848 x 848 pixels; no pharmacologic dilation:
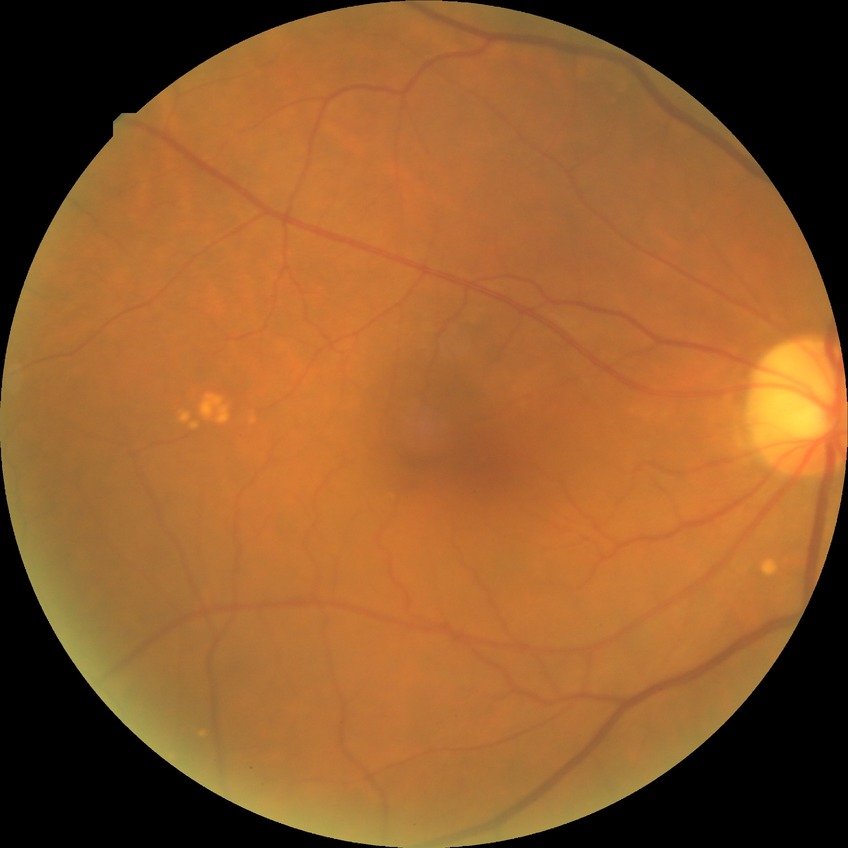 No diabetic retinal disease findings. DR grade: NDR.